Portable fundus photograph: 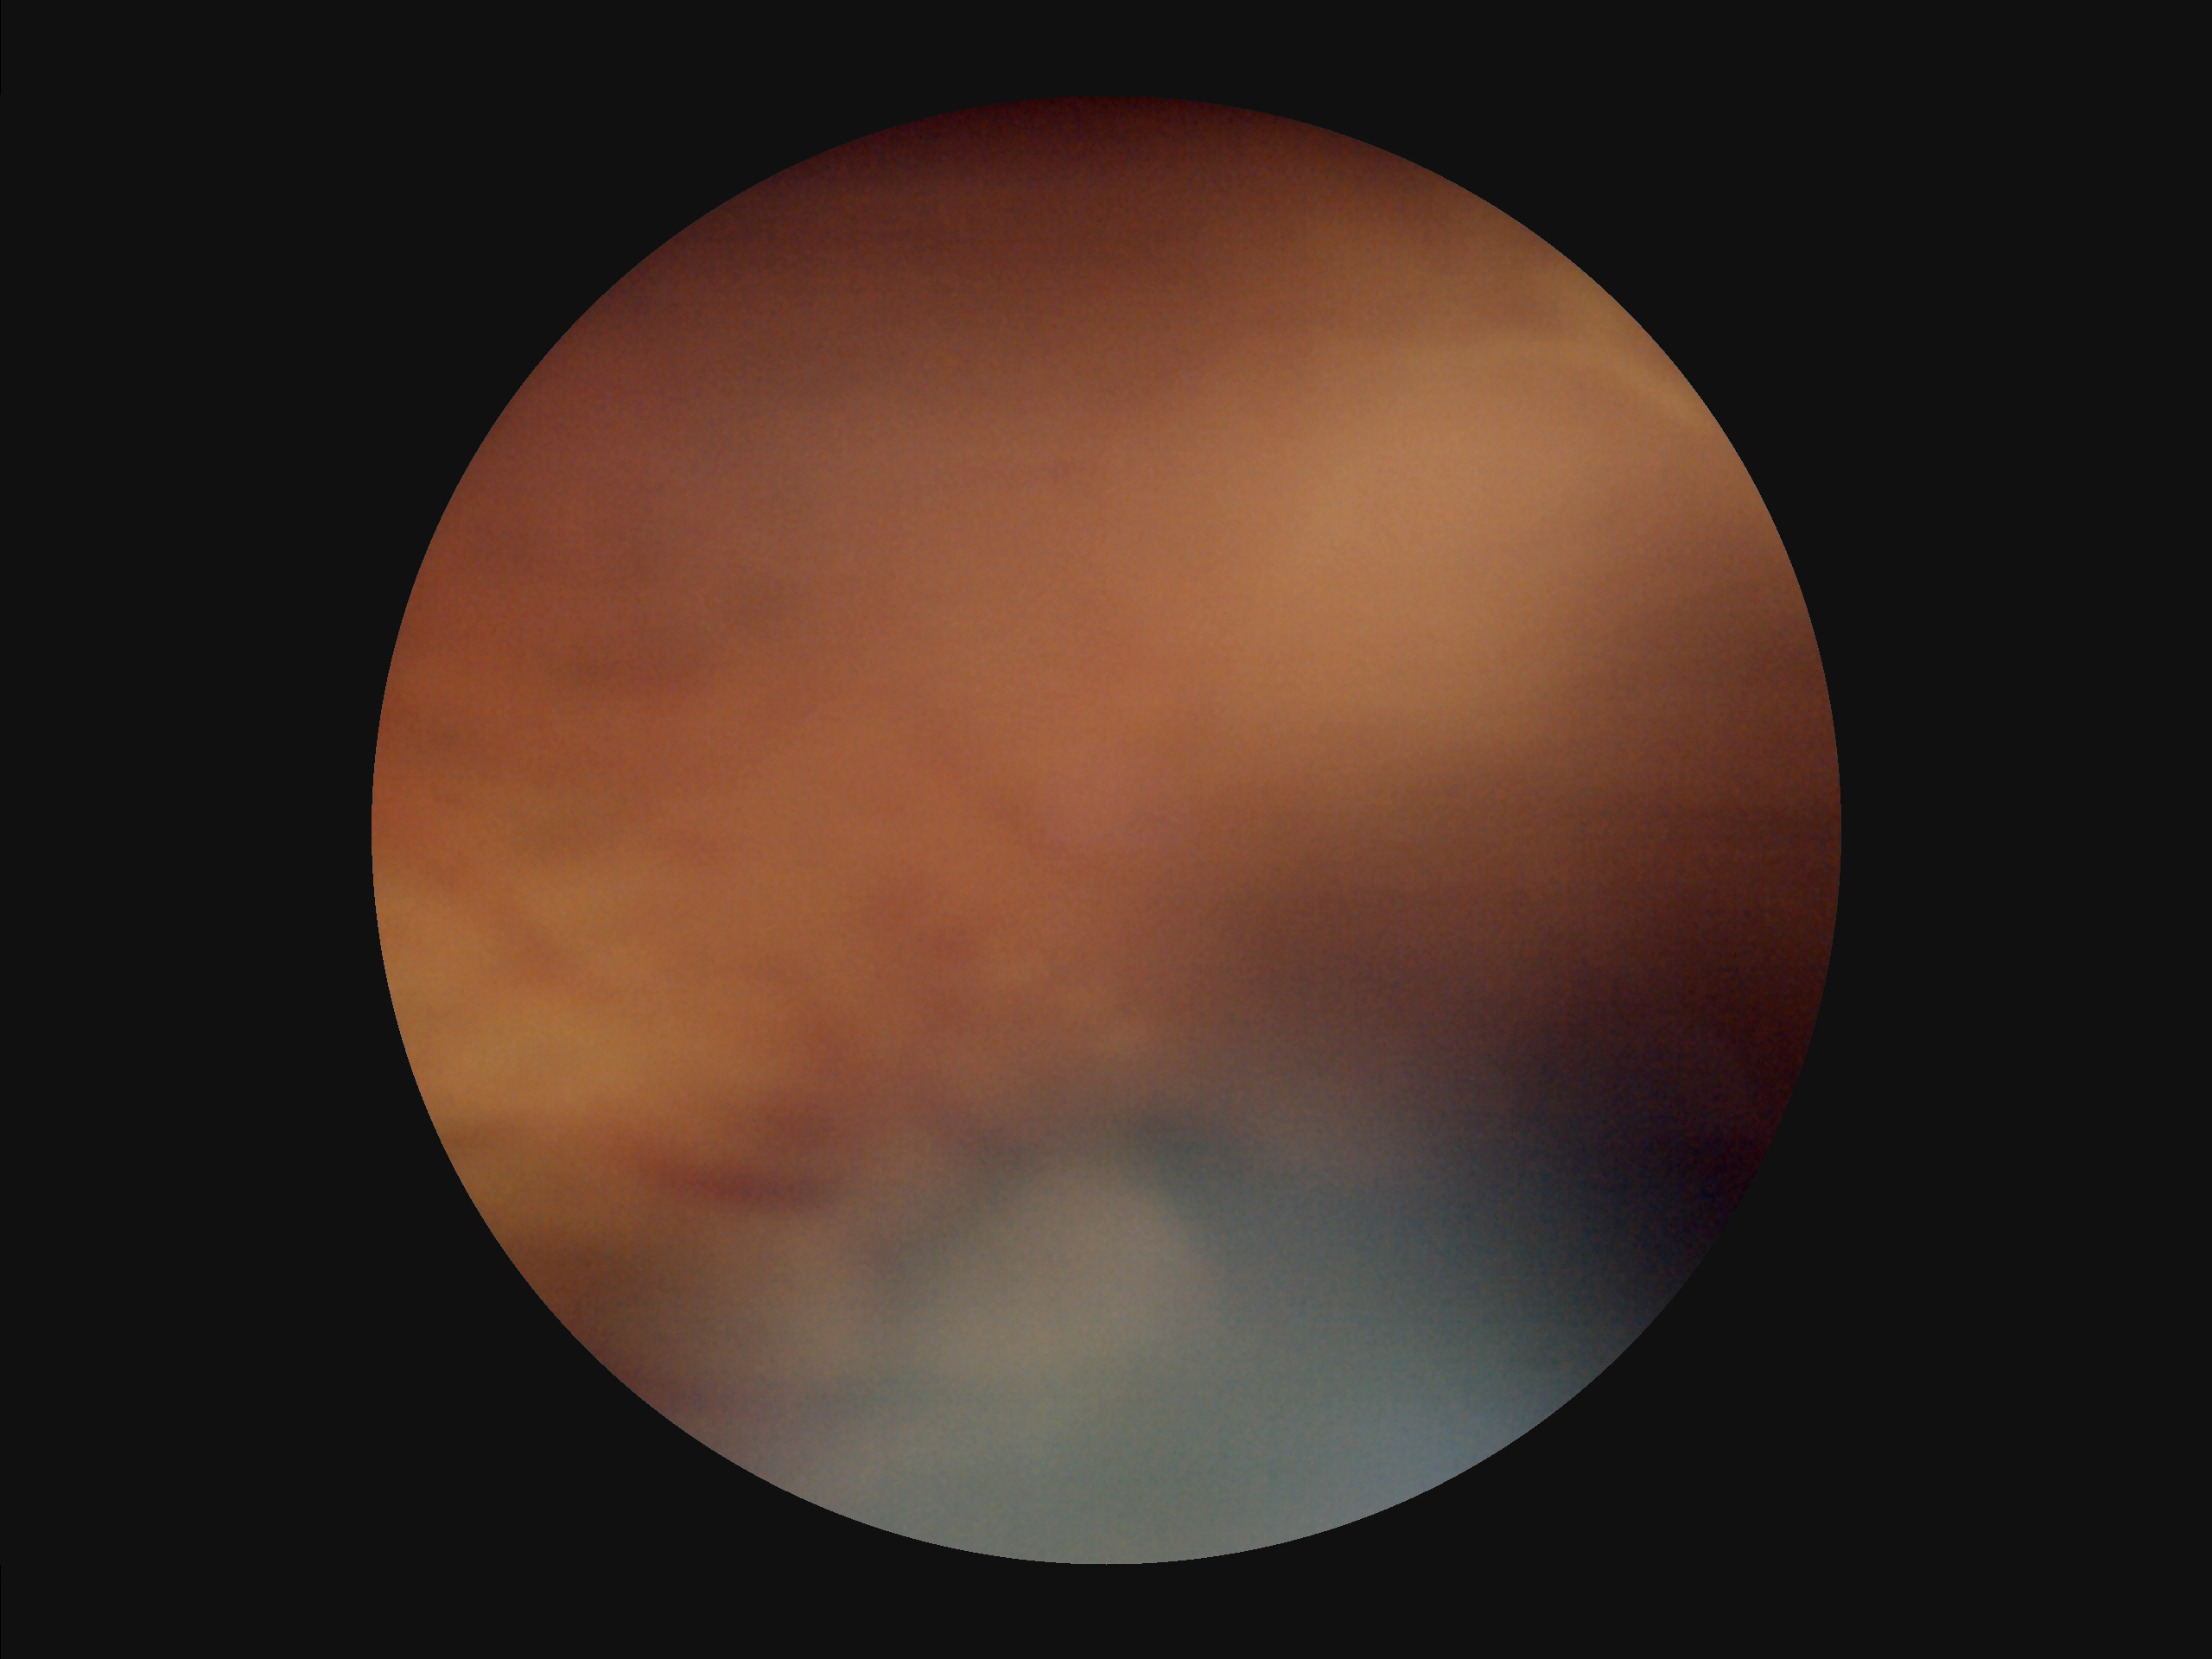 Overall quality = poor
Contrast = reduced
Illumination = poor
Focus = out of focus